Color fundus image, 45° field of view.
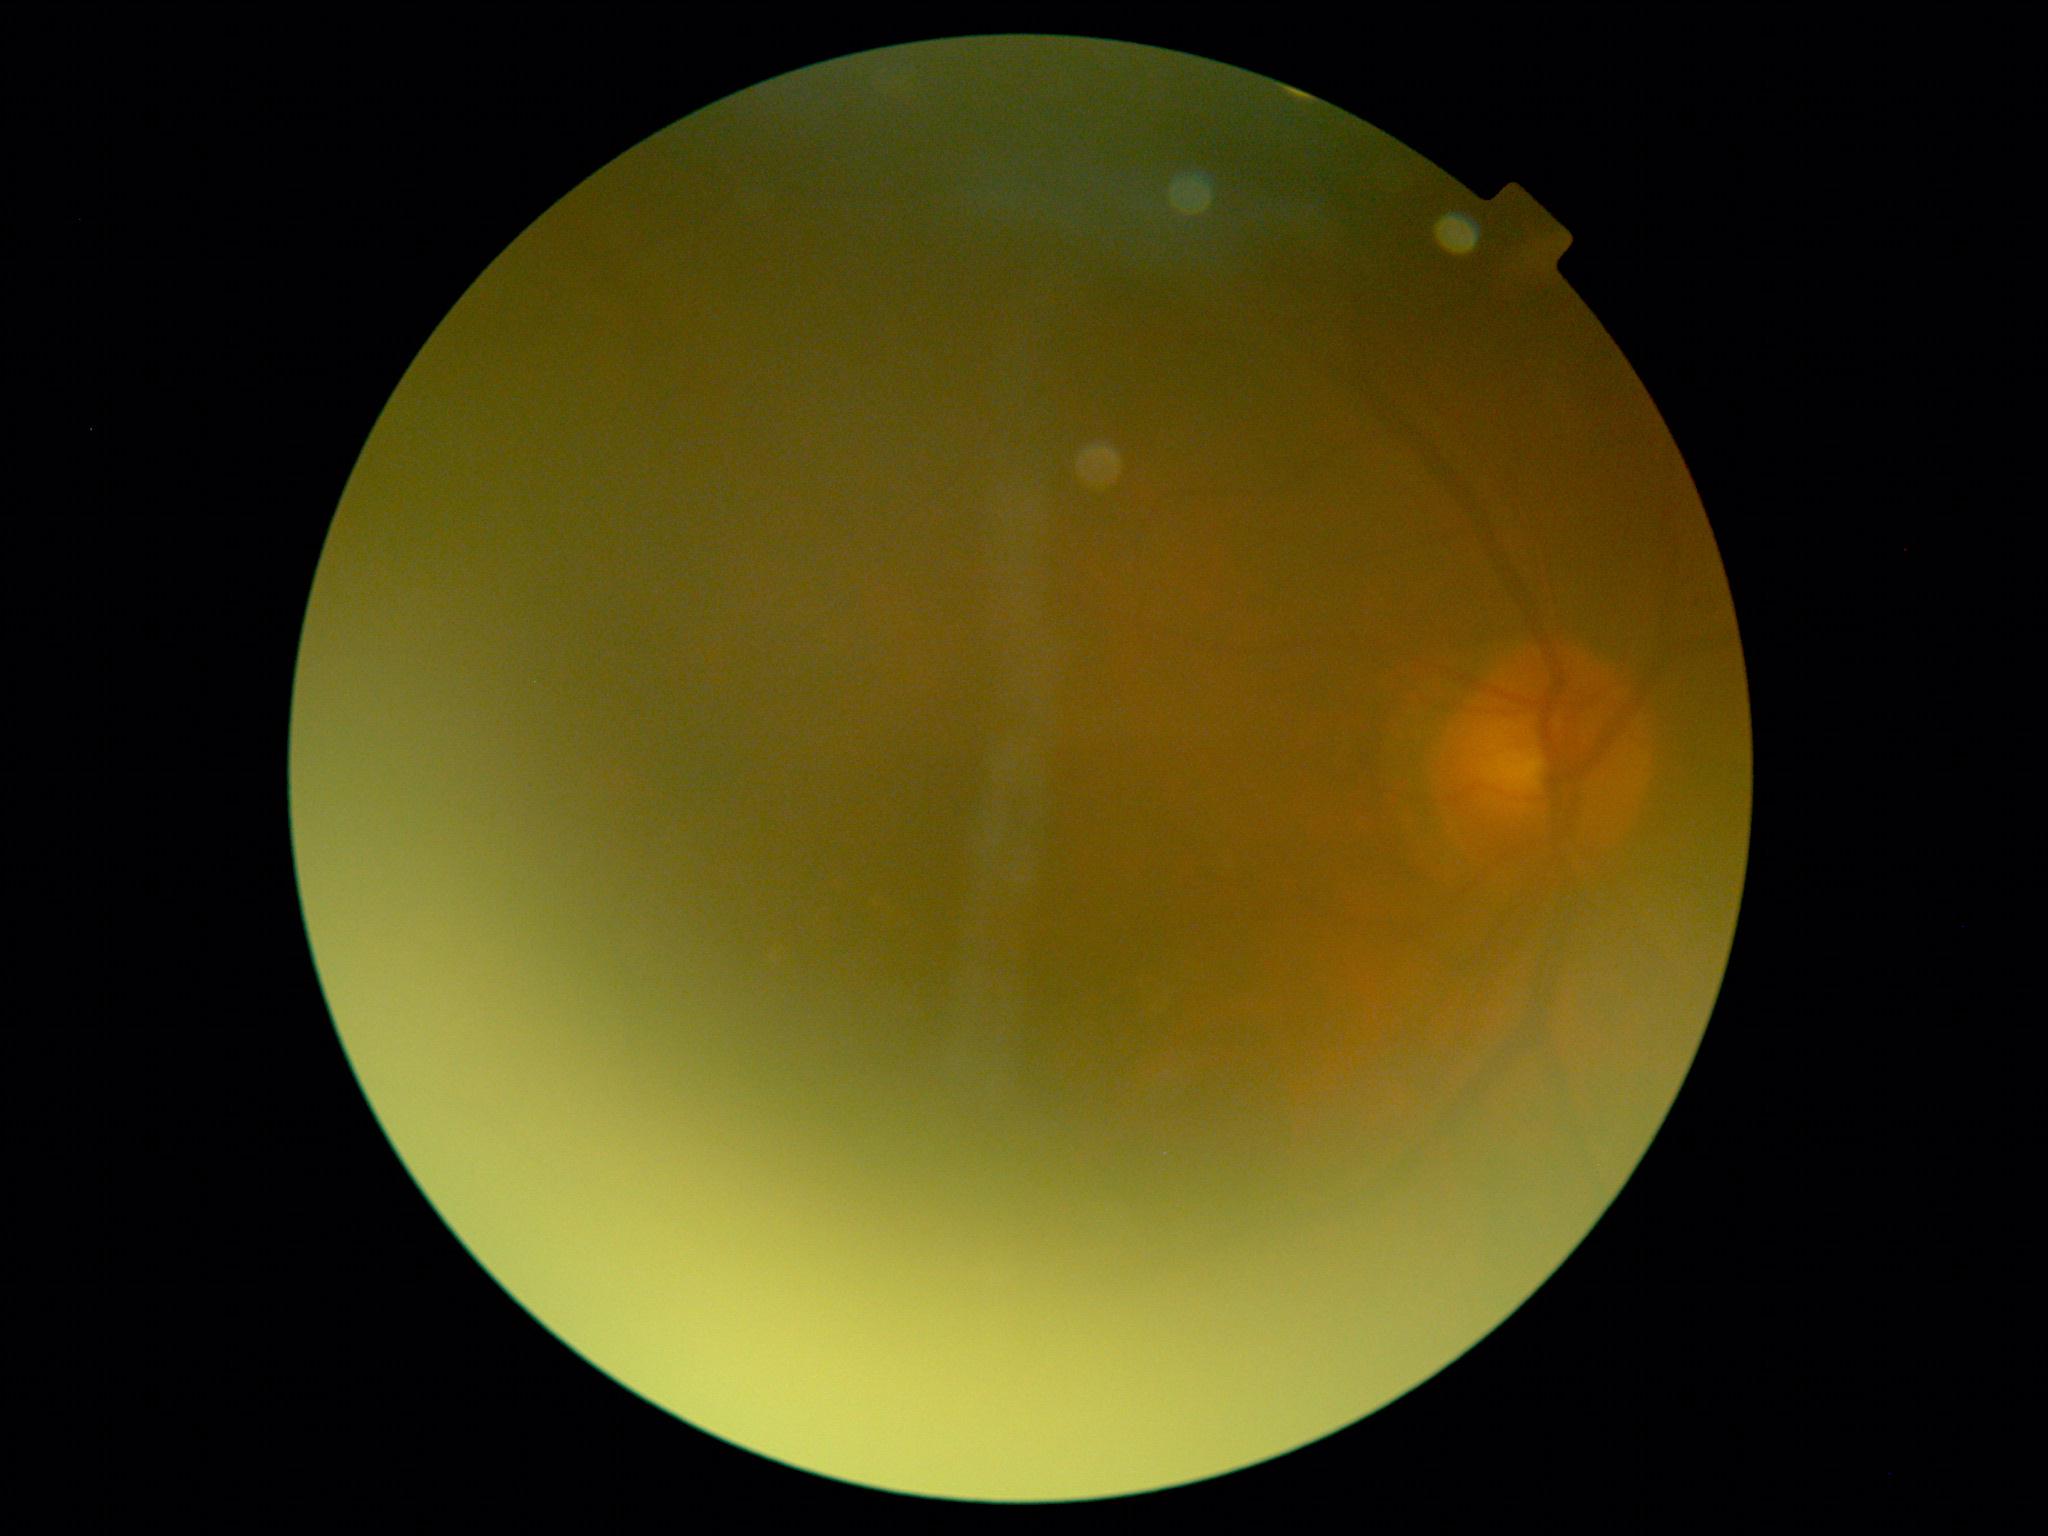

image quality: insufficient; diabetic retinopathy (DR): ungradable.